45° field of view. NIDEK AFC-230. Without pupil dilation:
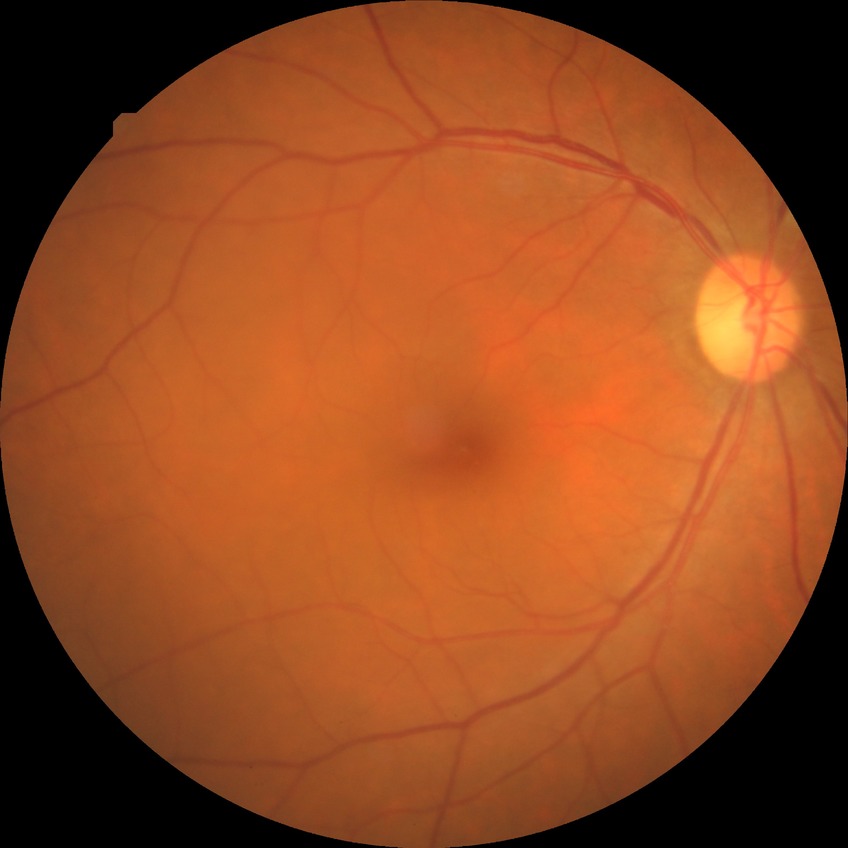

Diabetic retinopathy (DR) is no diabetic retinopathy (NDR).